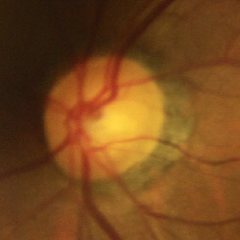
Optic disc appearance consistent with no glaucomatous findings.